1240x1240; pediatric wide-field fundus photograph.
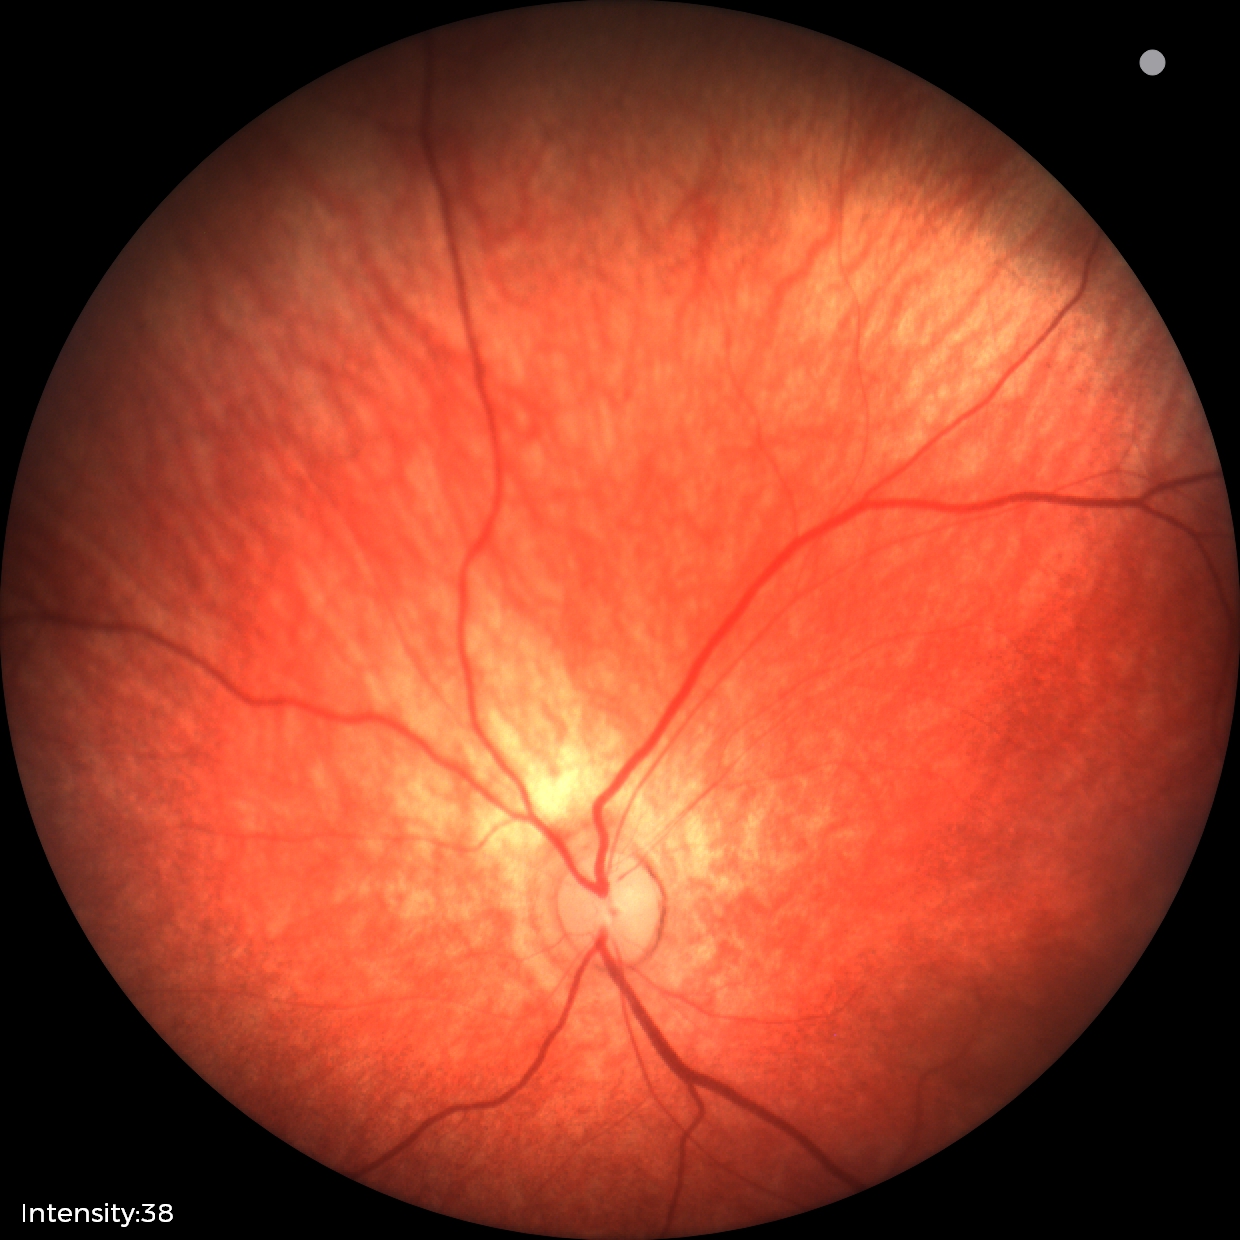
Examination with physiological retinal findings.